FOV: 45 degrees; CFP; 2352 x 1568 pixels
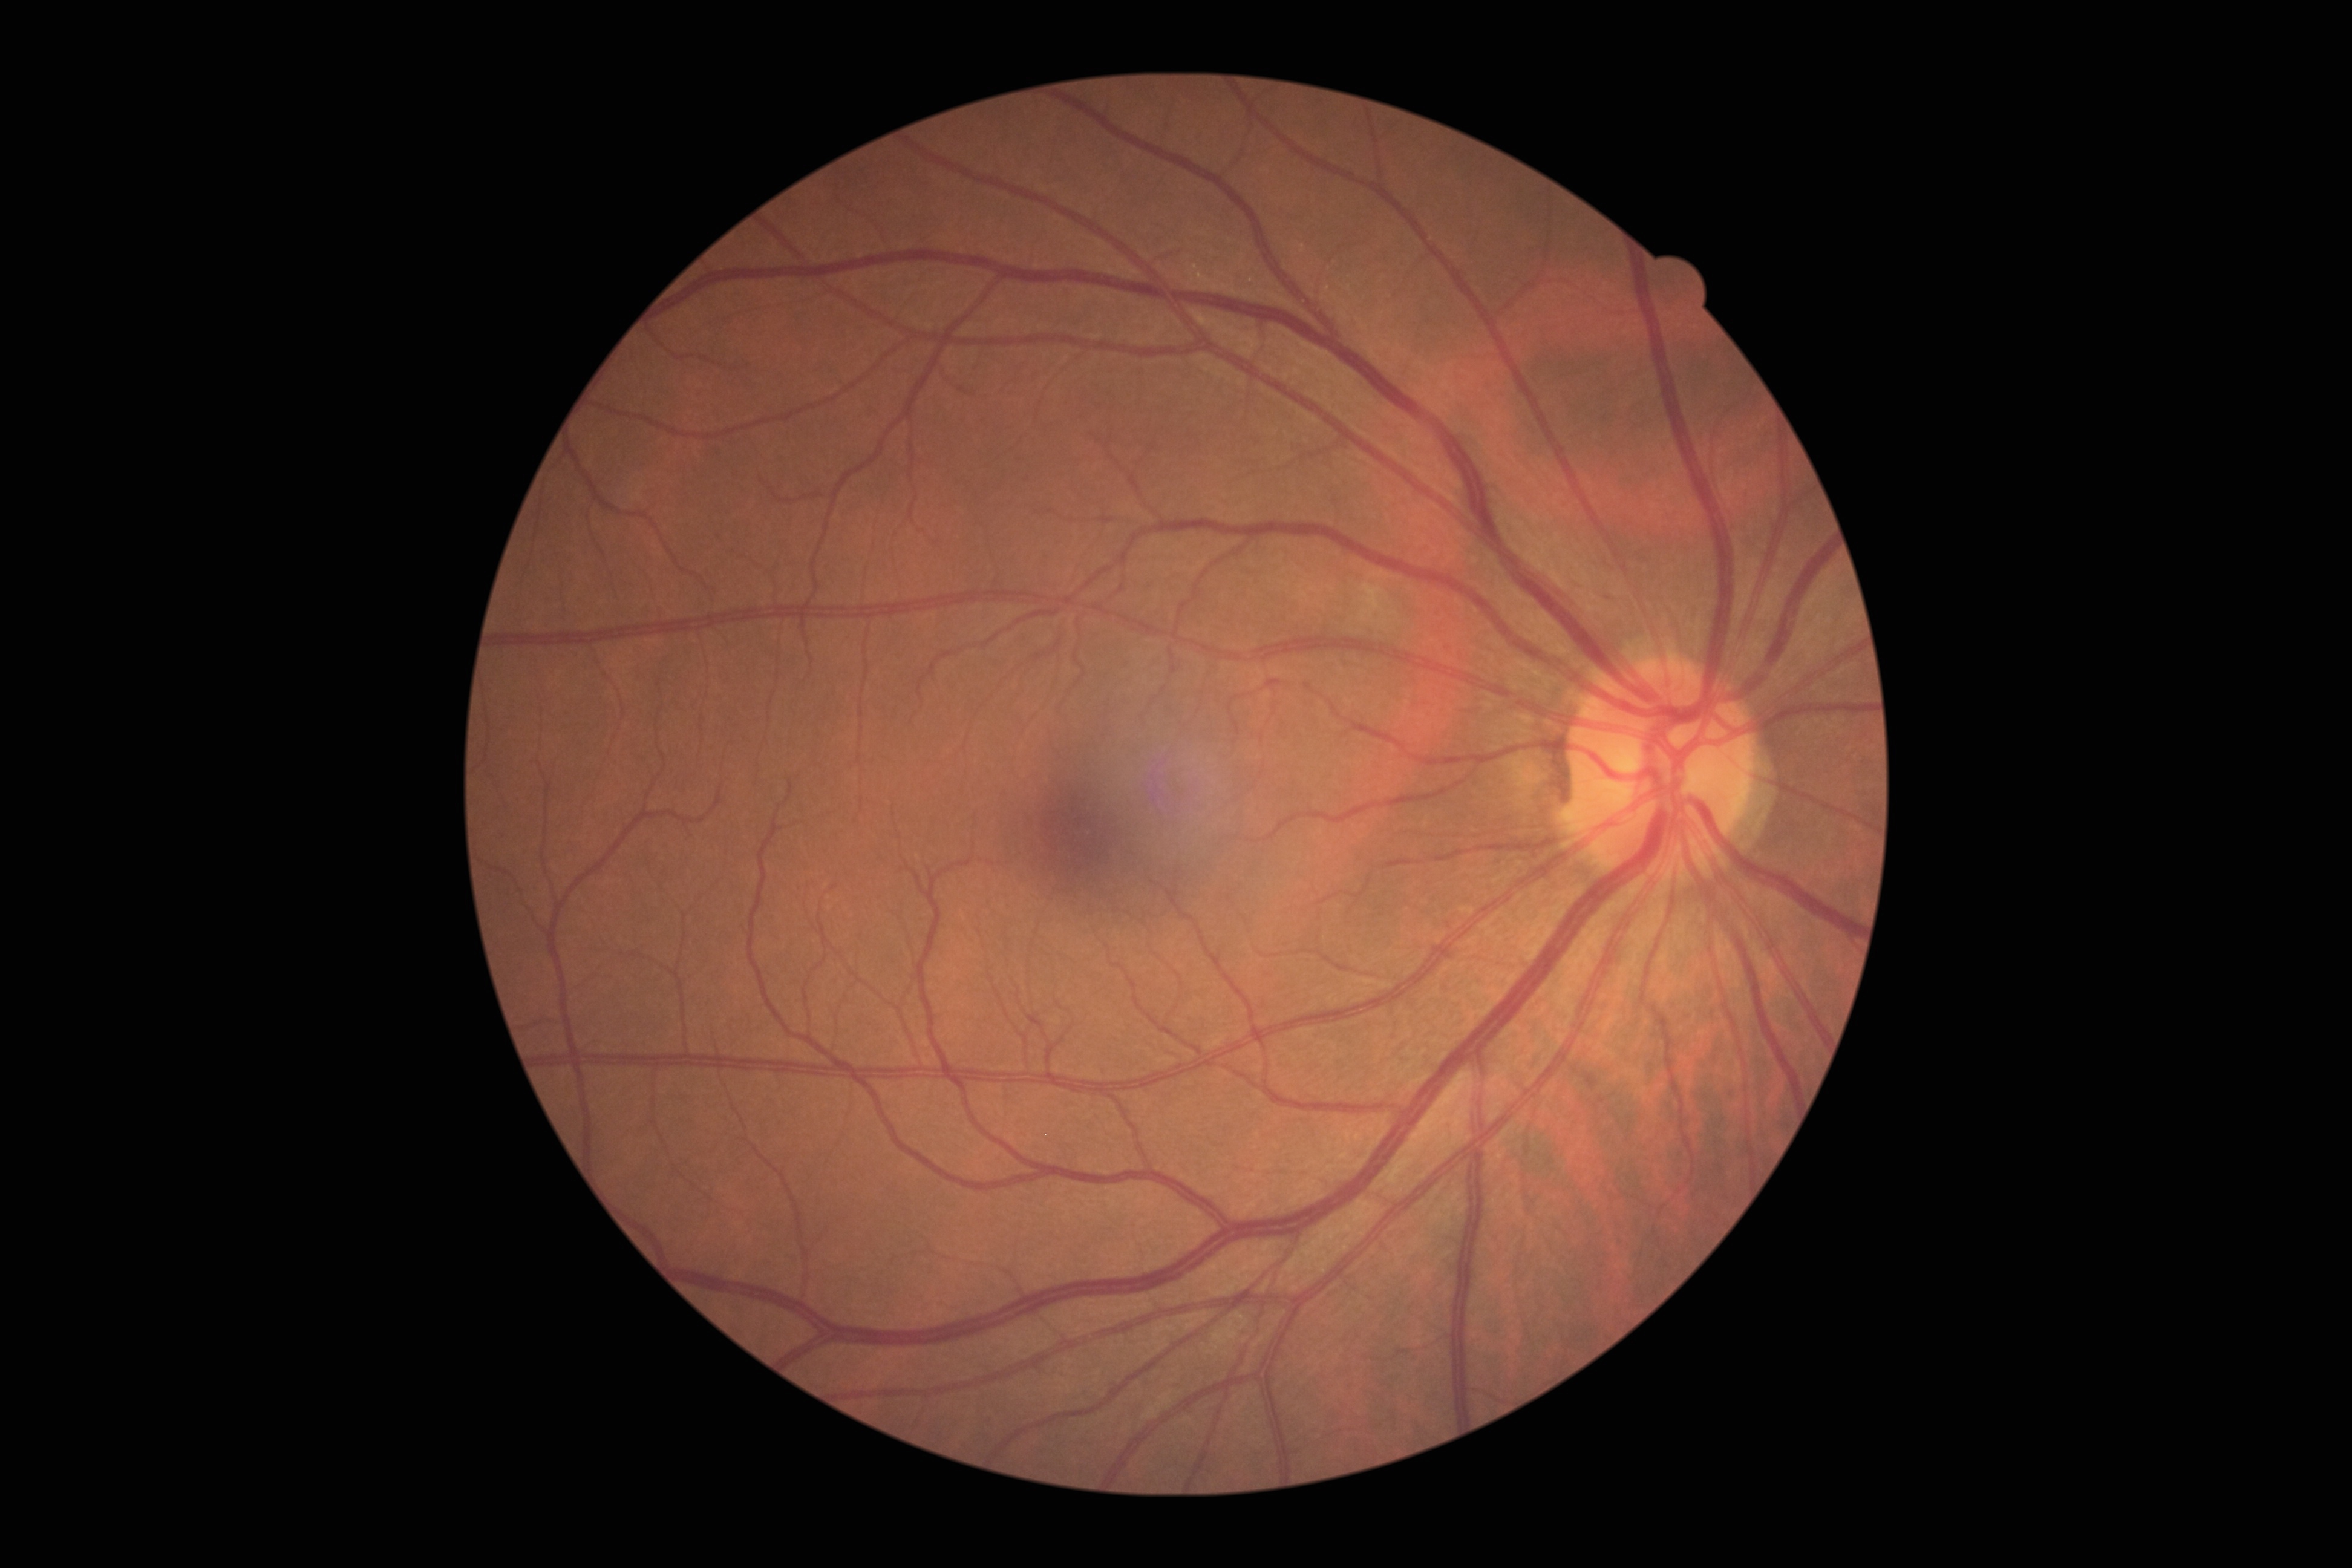
dr_grade: 0/4
dr_impression: no DR findings